Camera: NIDEK AFC-230 · 45° field of view · nonmydriatic fundus photograph:
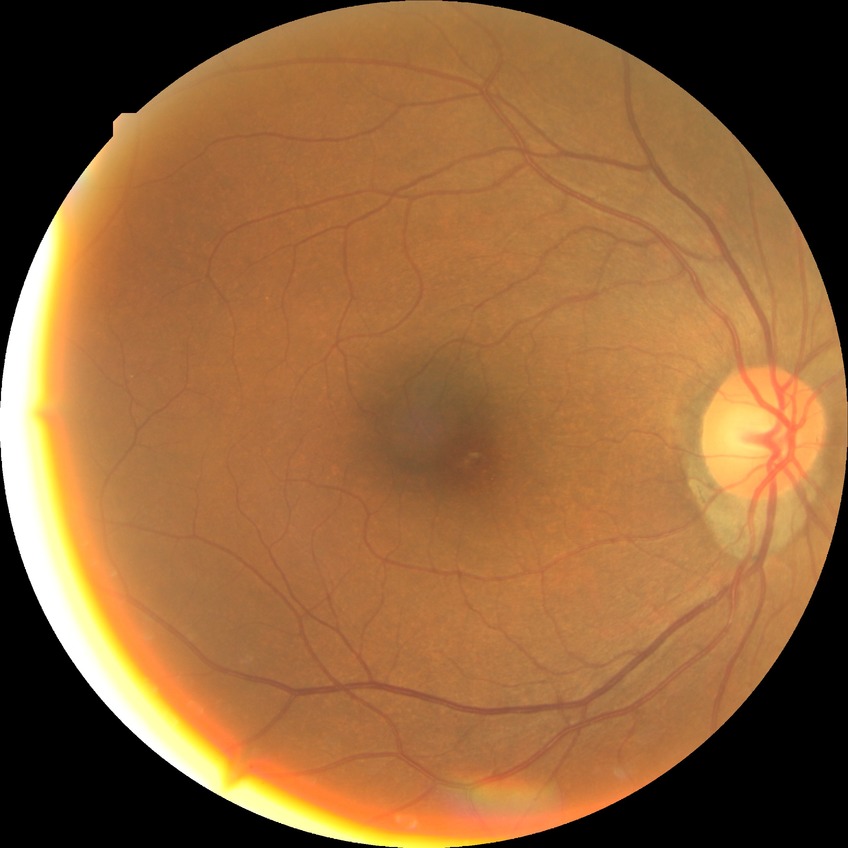
diabetic retinopathy (DR)=no diabetic retinopathy (NDR).